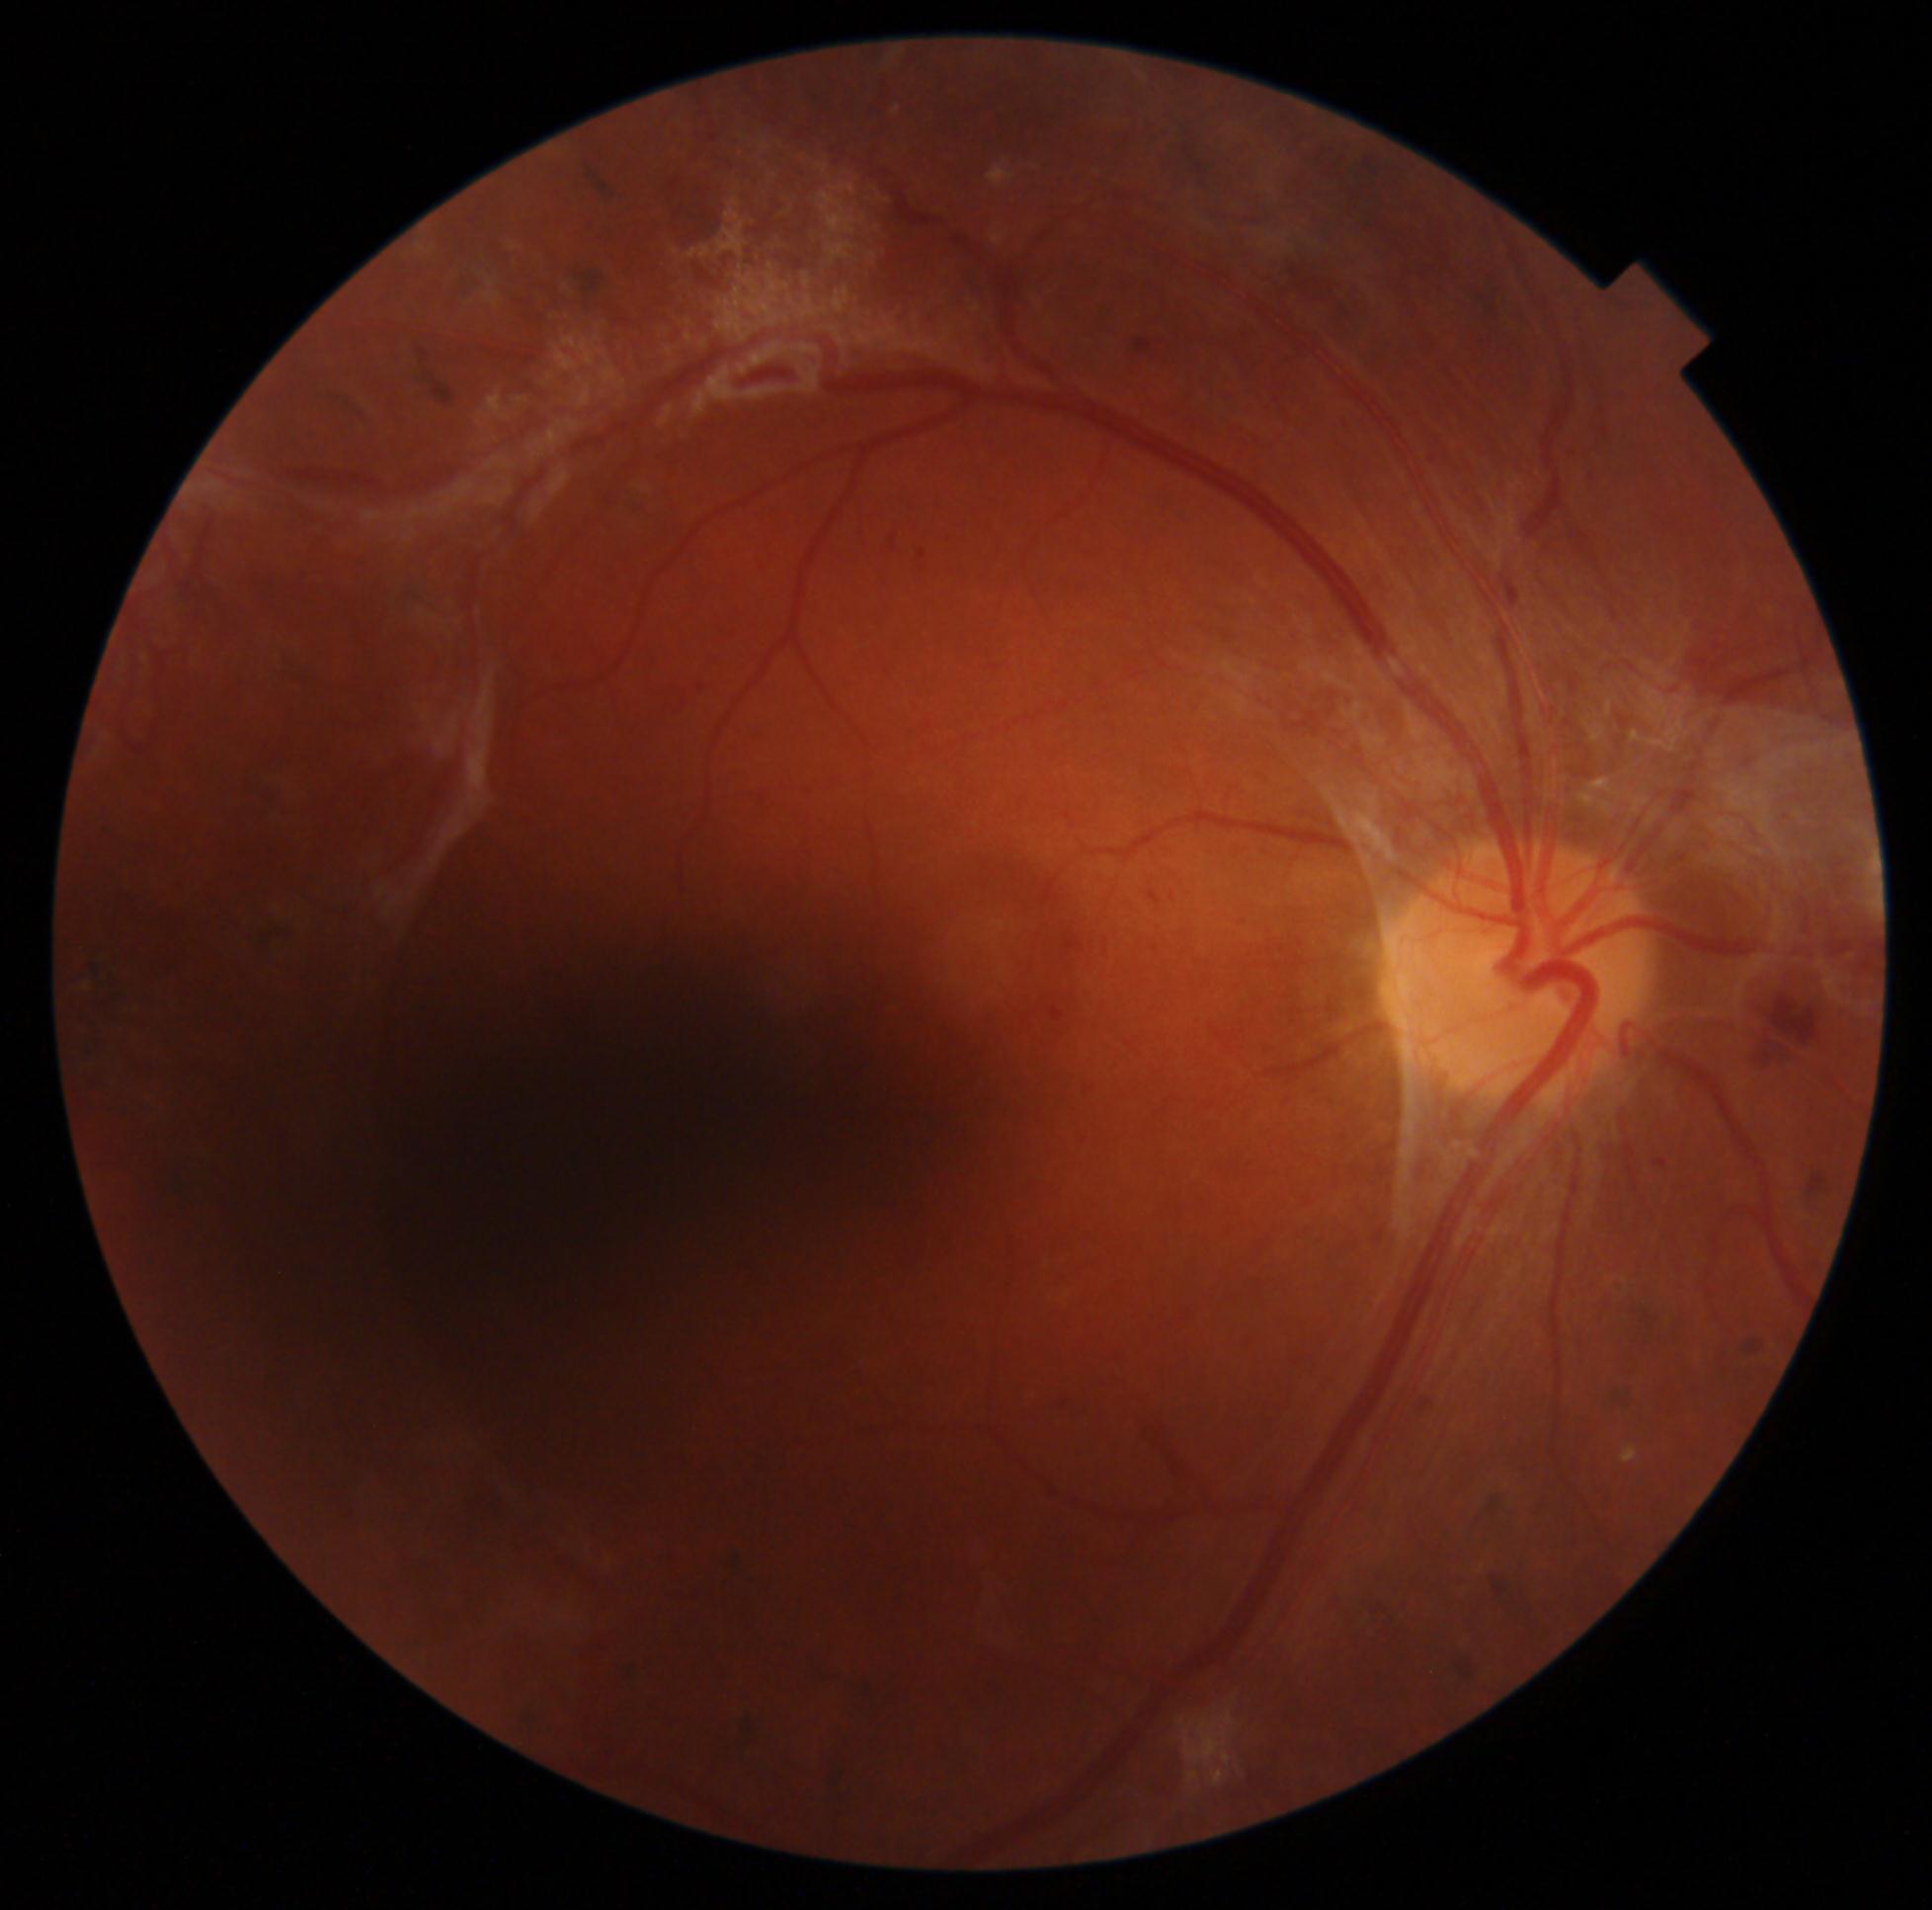 DR: proliferative diabetic retinopathy (grade 4). The retinopathy is classified as proliferative diabetic retinopathy.